Davis DR grading; retinal fundus photograph; camera: NIDEK AFC-230; 848 by 848 pixels; 45-degree field of view.
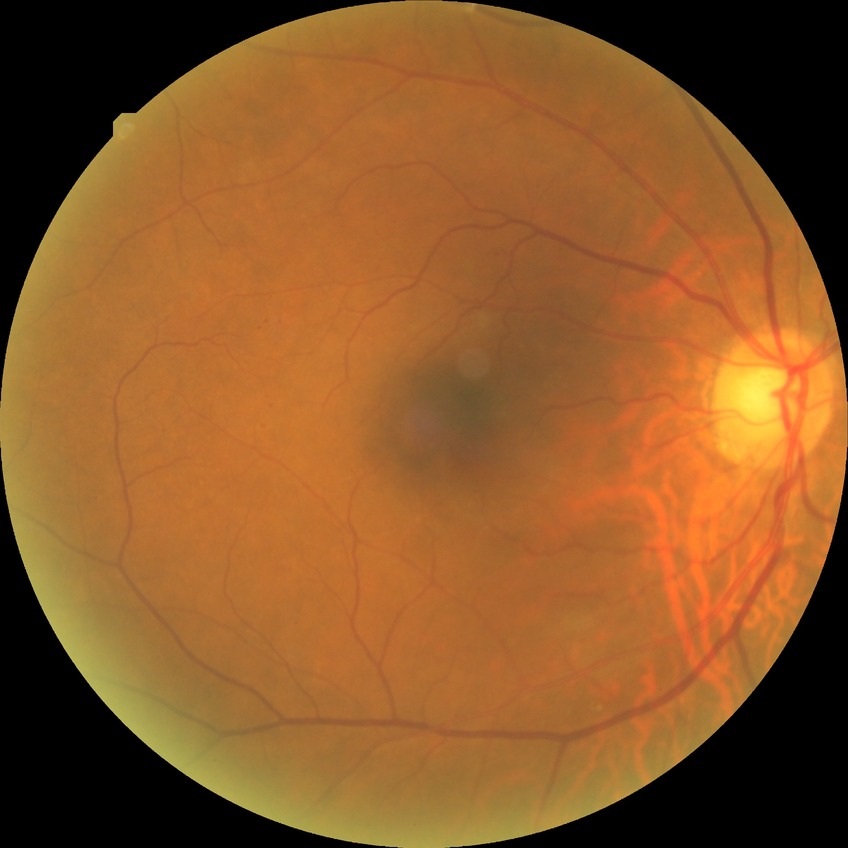
retinopathy stage: simple diabetic retinopathy.